Optic disc-centered crop from a color fundus photograph — 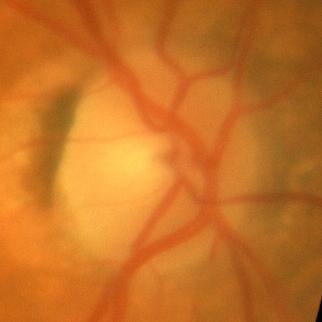 Q: Does this eye have glaucoma?
A: No — no glaucomatous findings.